Wide-field fundus photograph from neonatal ROP screening. Clarity RetCam 3, 130° FOV:
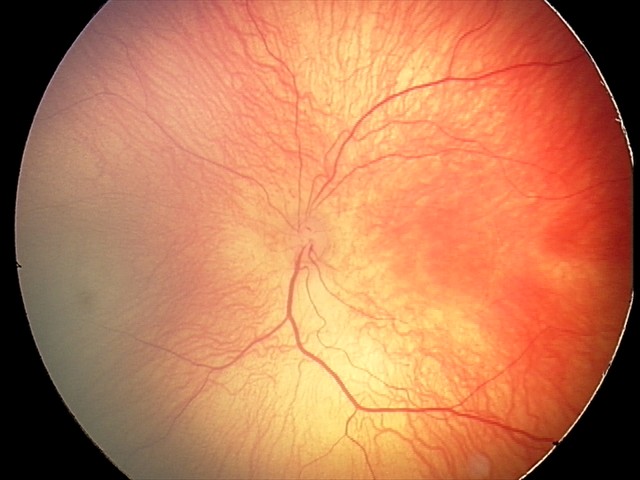

Impression: retinopathy of prematurity (ROP) stage 1.